Image size 848x848, graded on the modified Davis scale, color fundus photograph: 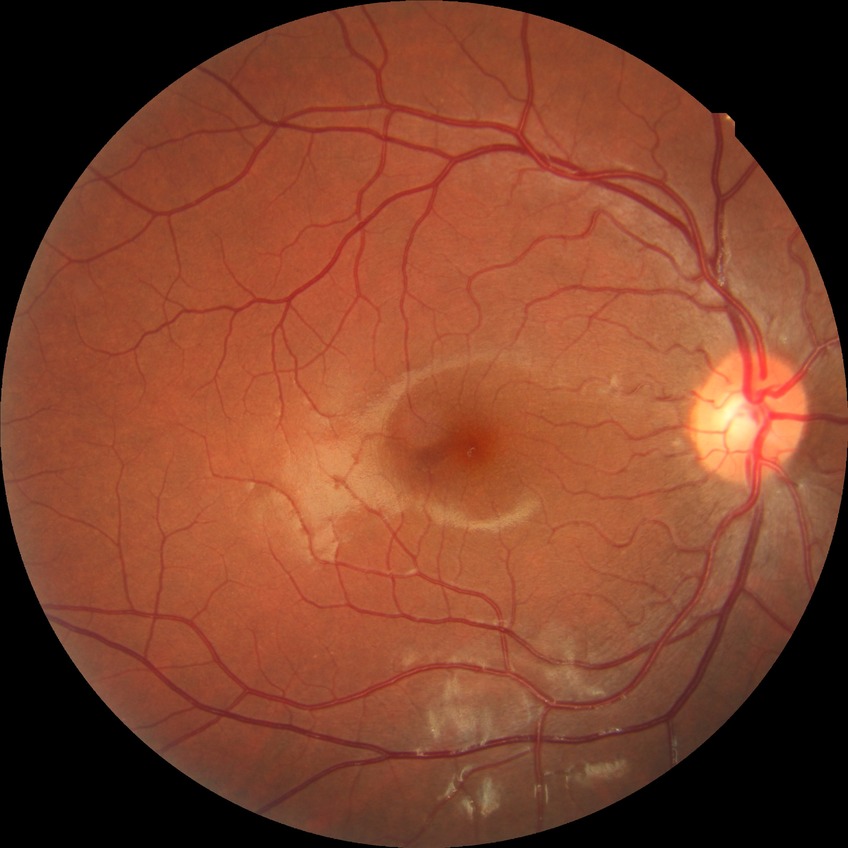

Retinopathy grade is no diabetic retinopathy.